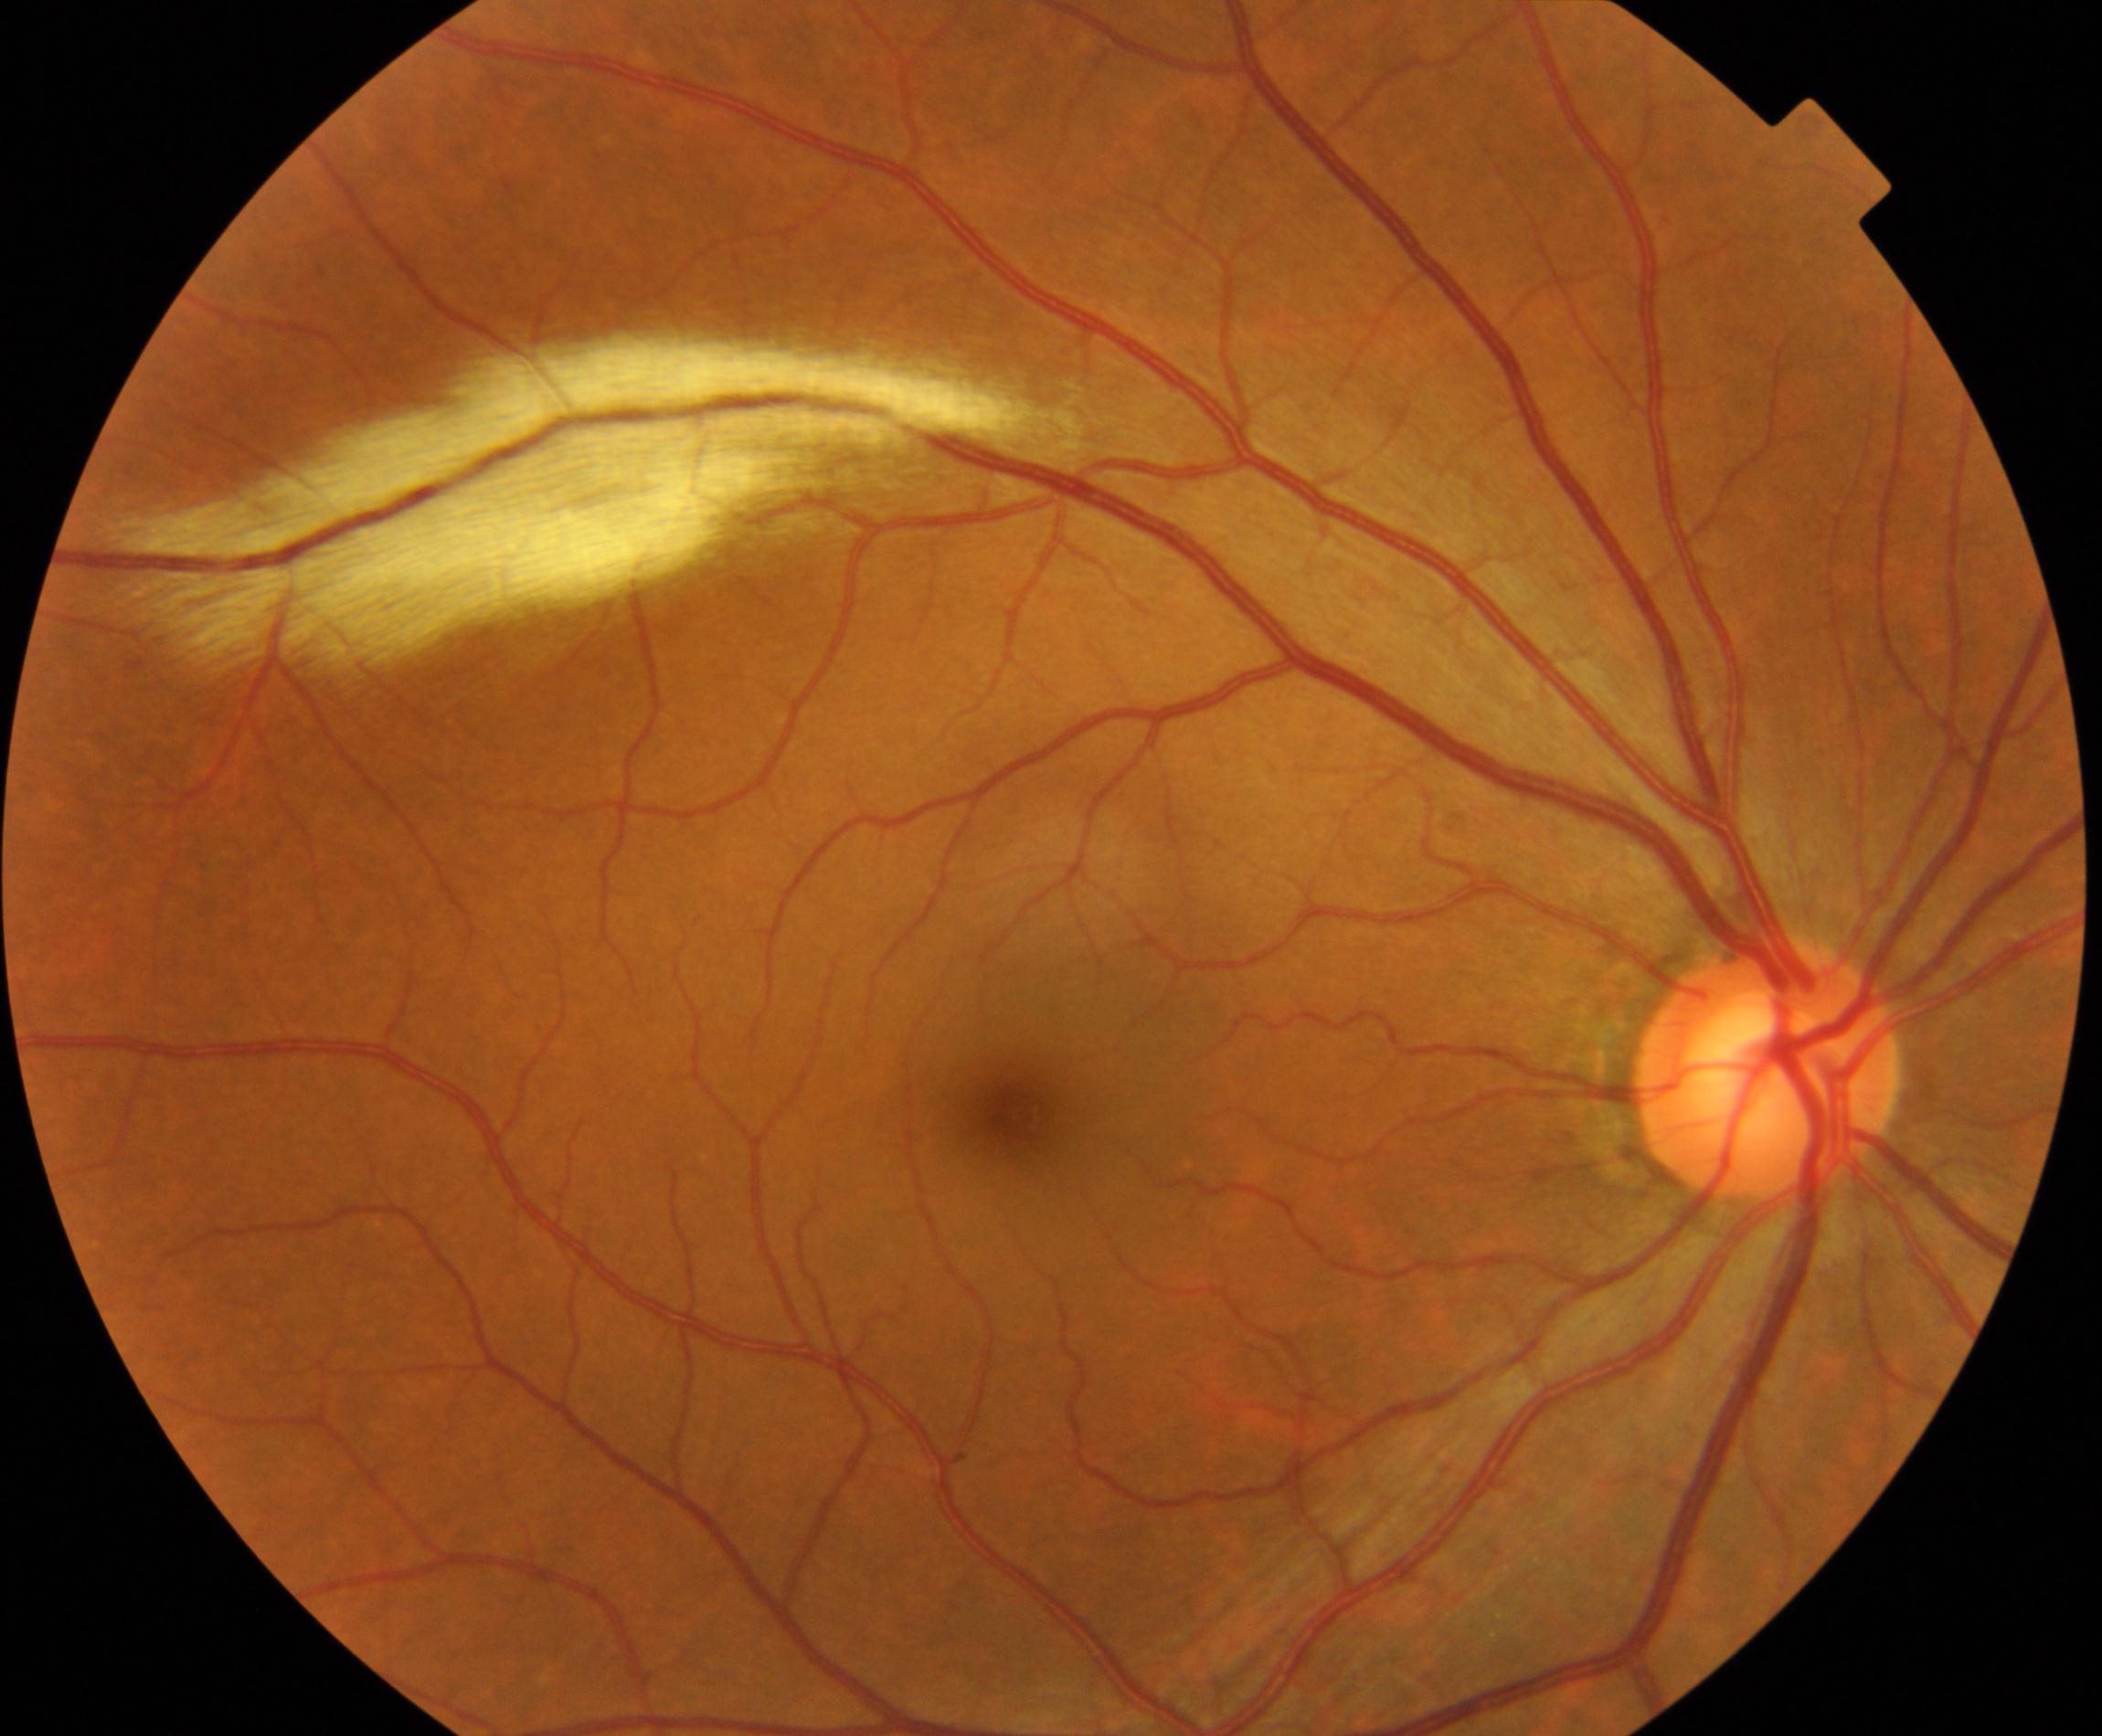

Findings: myelinated nerve fibers.